45° field of view · NIDEK AFC-230 fundus camera — 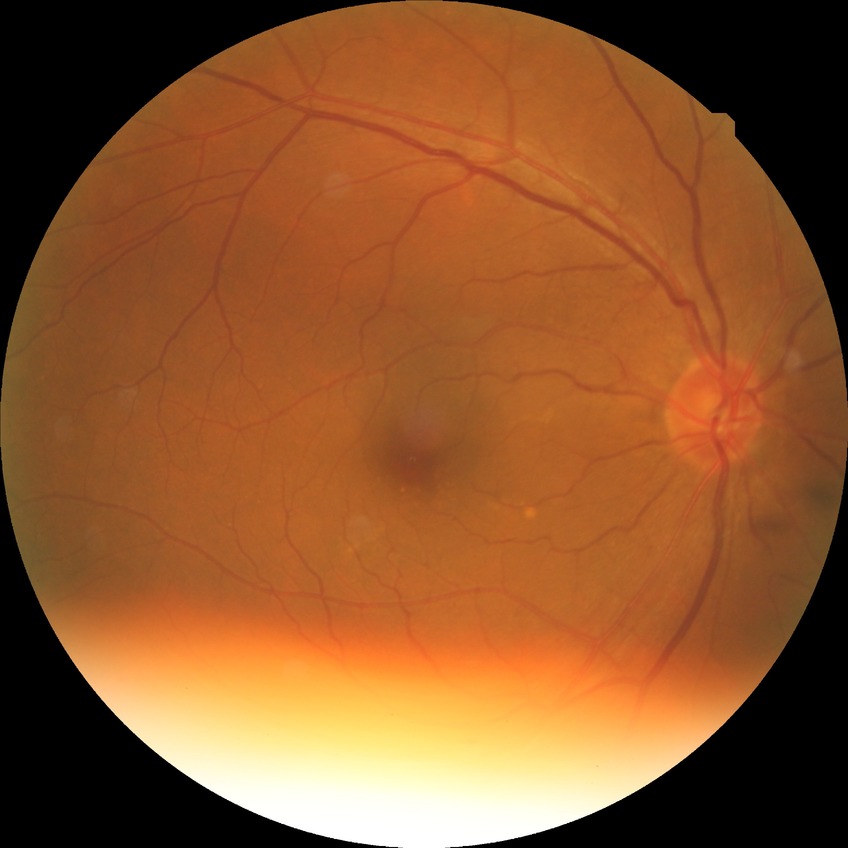

  davis_grade: no diabetic retinopathy